ONH-centered crop from a color fundus image.
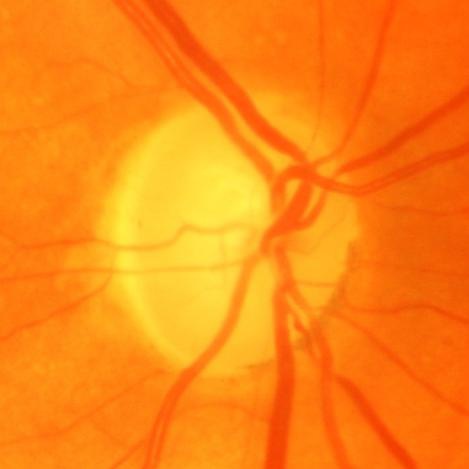
Diagnosis = evidence of glaucoma.